Color fundus photograph. 848 by 848 pixels: 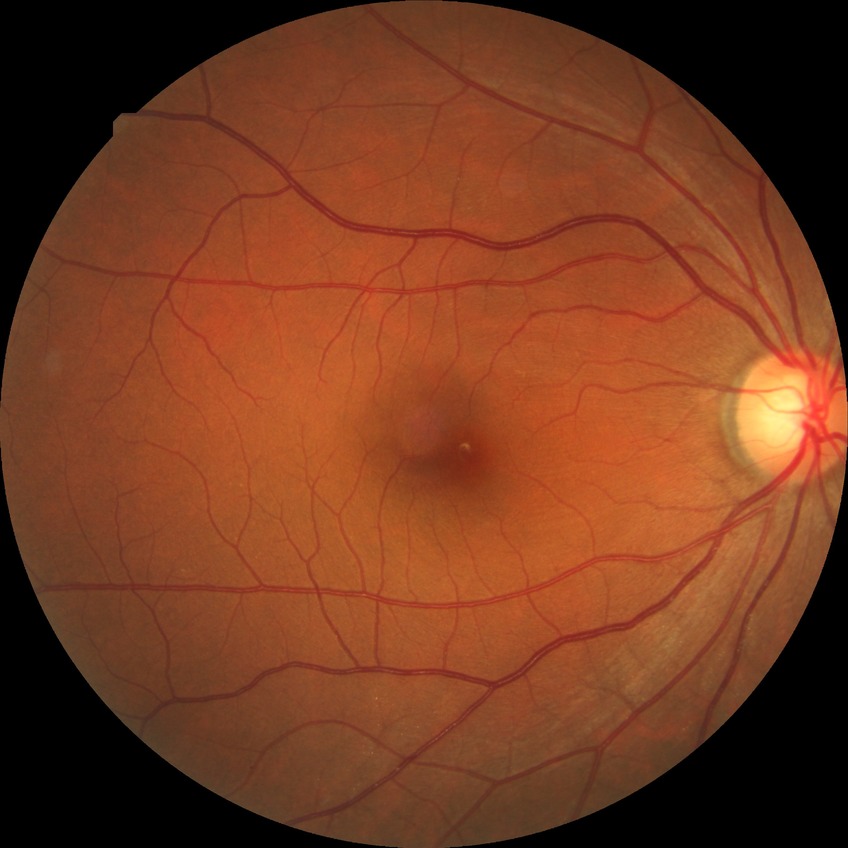 Diabetic retinopathy (DR): no diabetic retinopathy (NDR).